Davis DR grading — 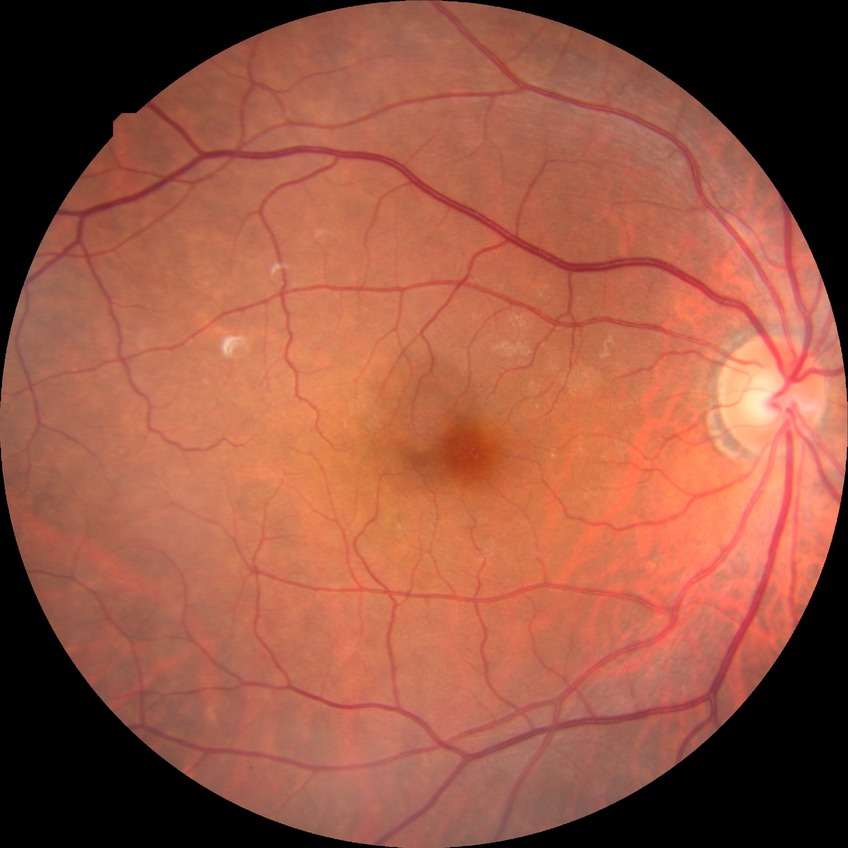
Diabetic retinopathy (DR) is NDR (no diabetic retinopathy).